640 by 480 pixels; wide-field fundus photograph from neonatal ROP screening; 130° field of view (Clarity RetCam 3) — 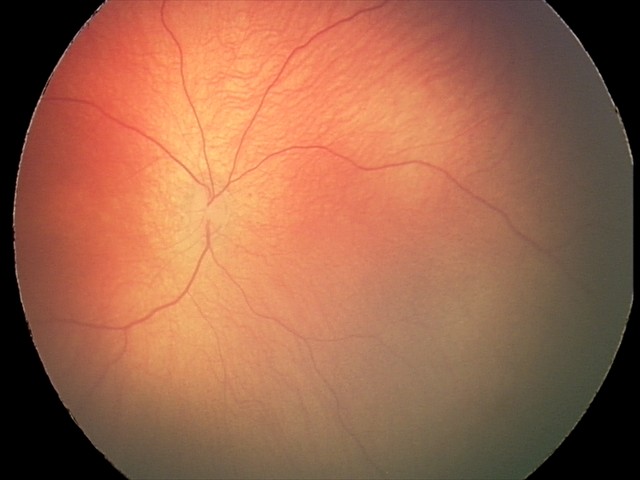 Screening examination diagnosed as physiological.